Retinal fundus photograph: 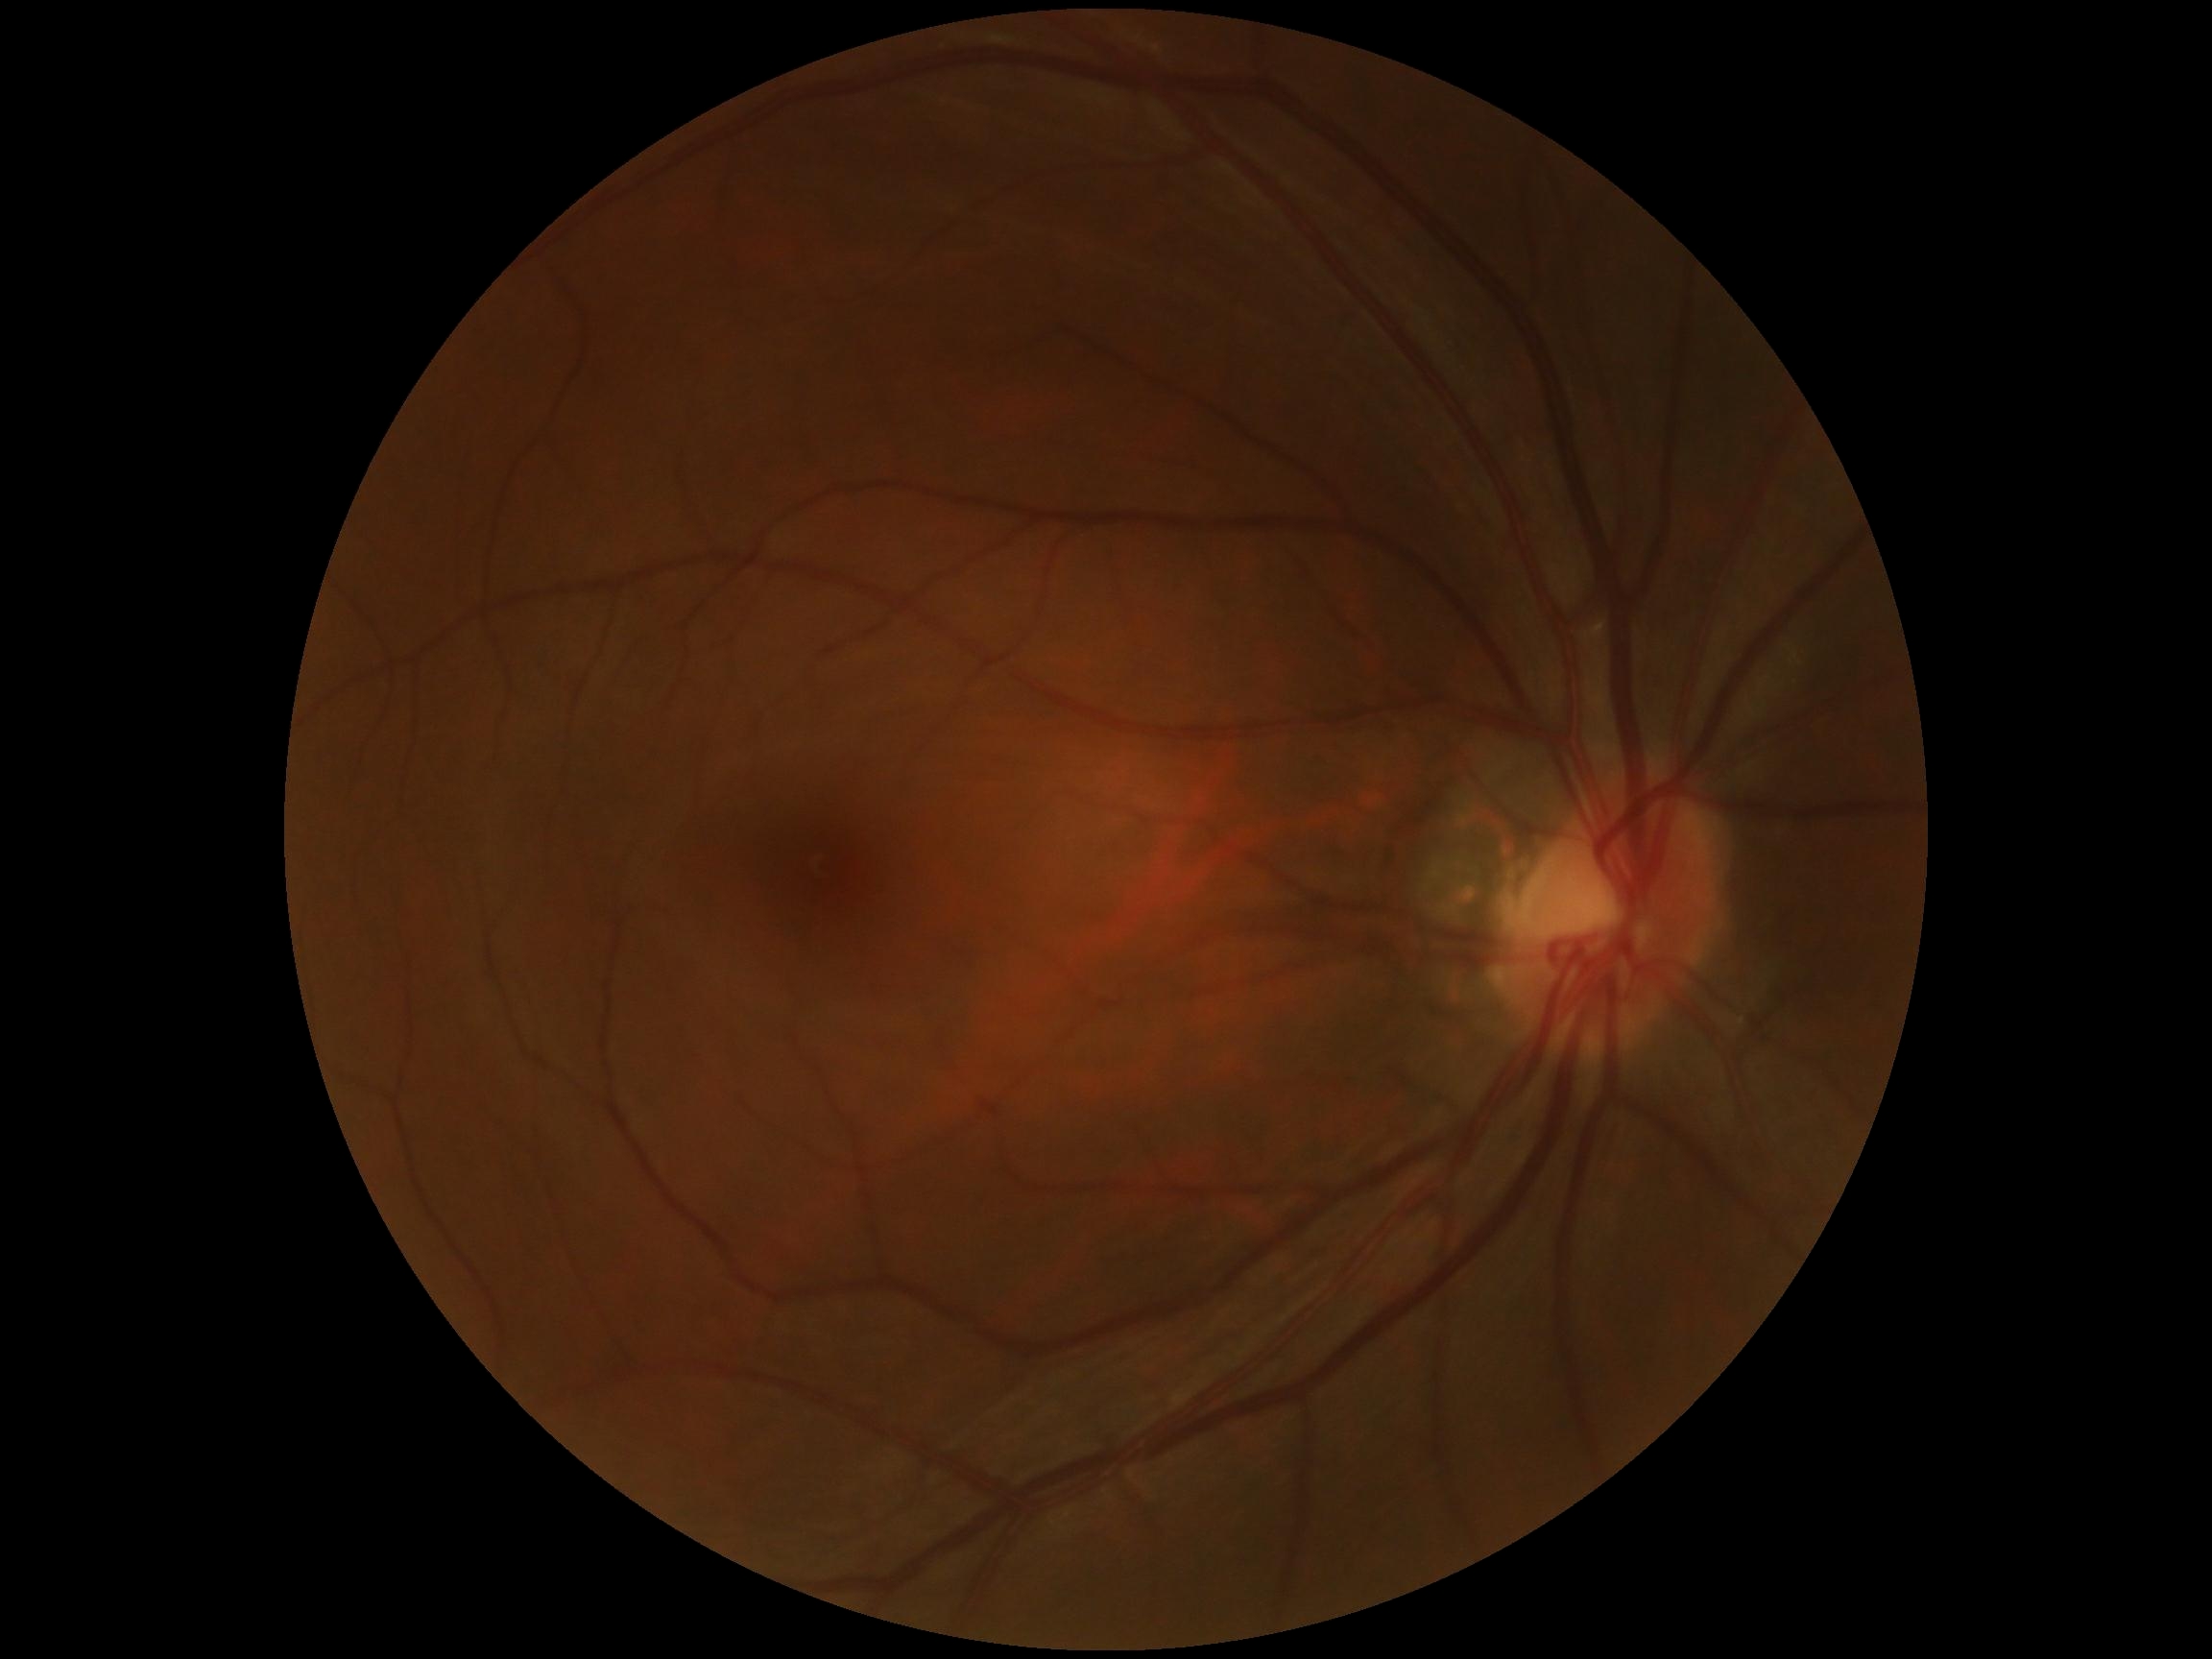

No signs of diabetic retinopathy. DR severity: grade 0 (no apparent retinopathy) — no visible signs of diabetic retinopathy.